2212 x 1661 pixels. Pachymetry 554 µm.
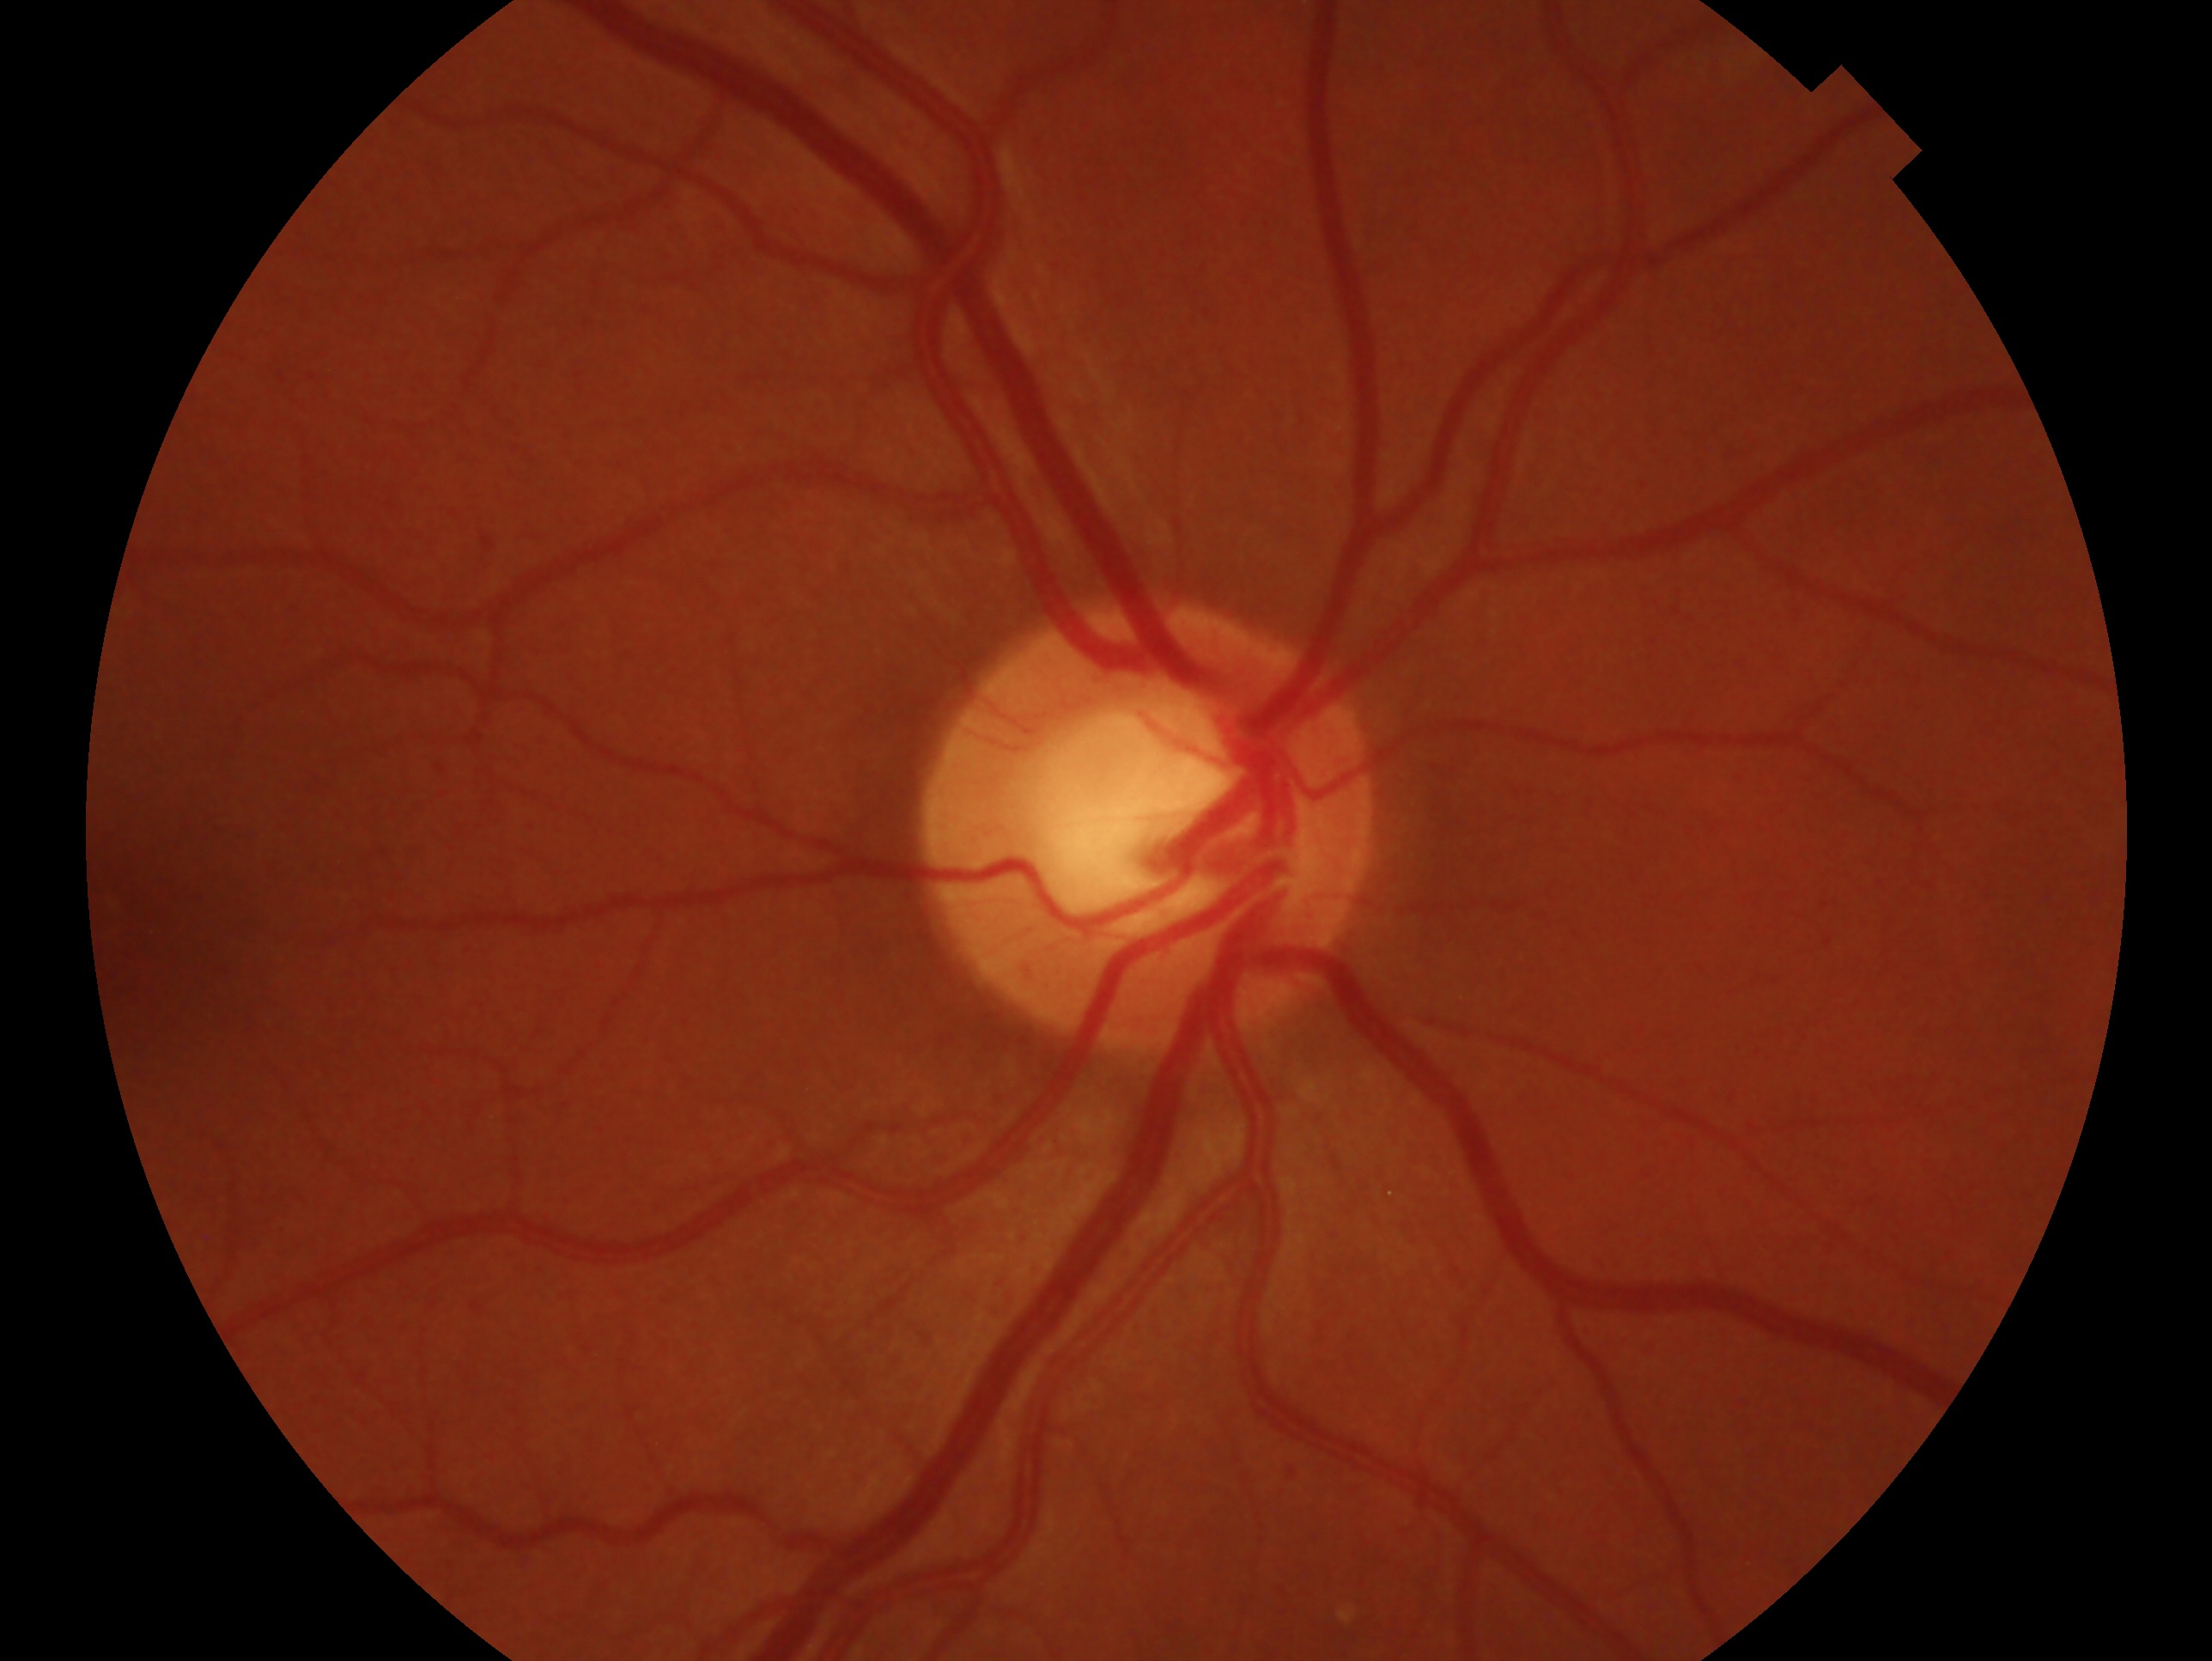
- eye: OD
- diagnosis: glaucoma suspect